Wide-field fundus image from infant ROP screening; 640x480px
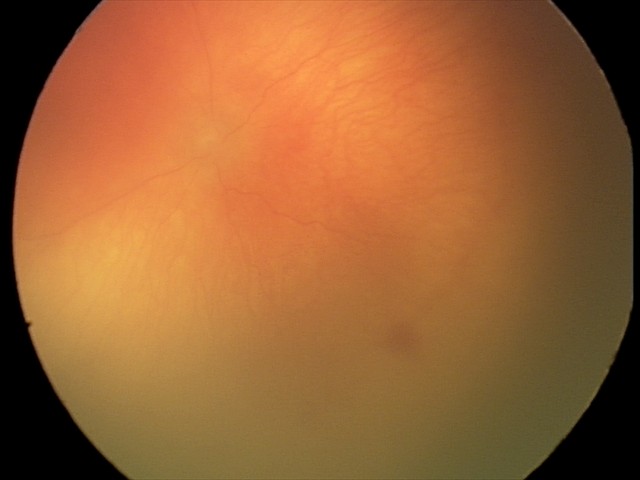 Plus disease was diagnosed.
Examination diagnosed as A-ROP (aggressive ROP).